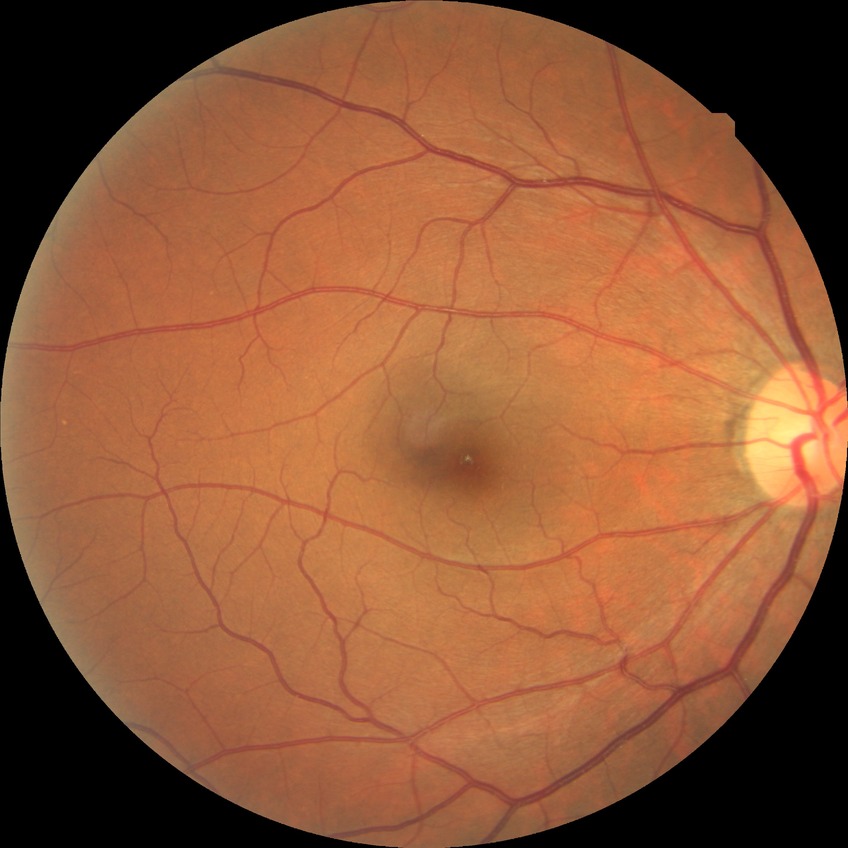
No apparent diabetic retinopathy.
DR: NDR.